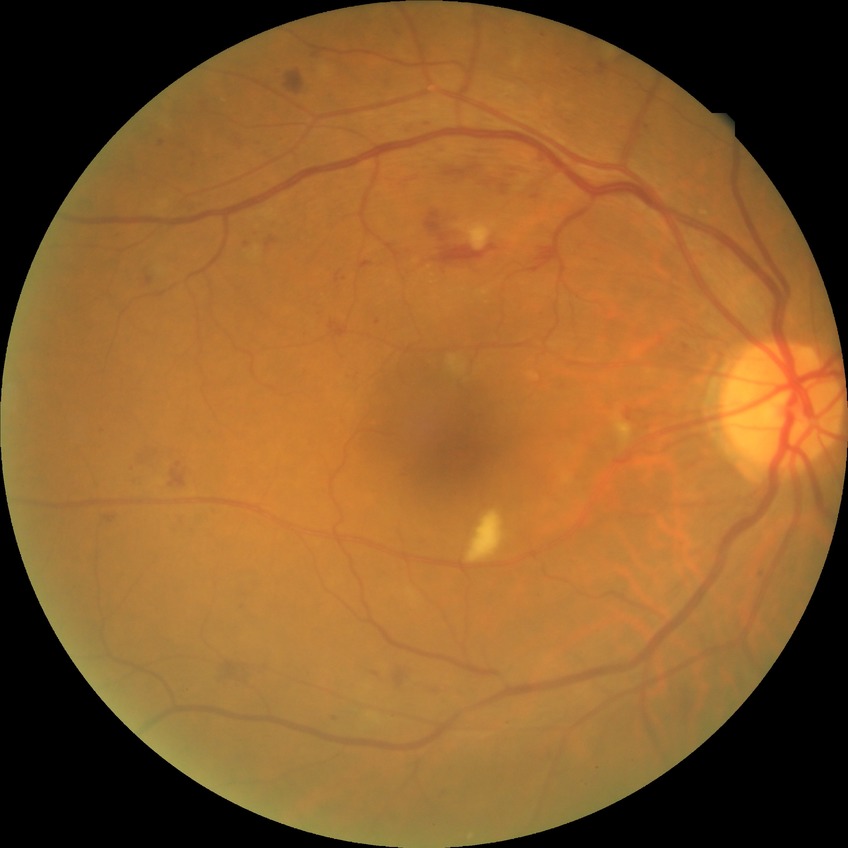

Assessment:
• diabetic retinopathy (DR): PPDR (pre-proliferative diabetic retinopathy)